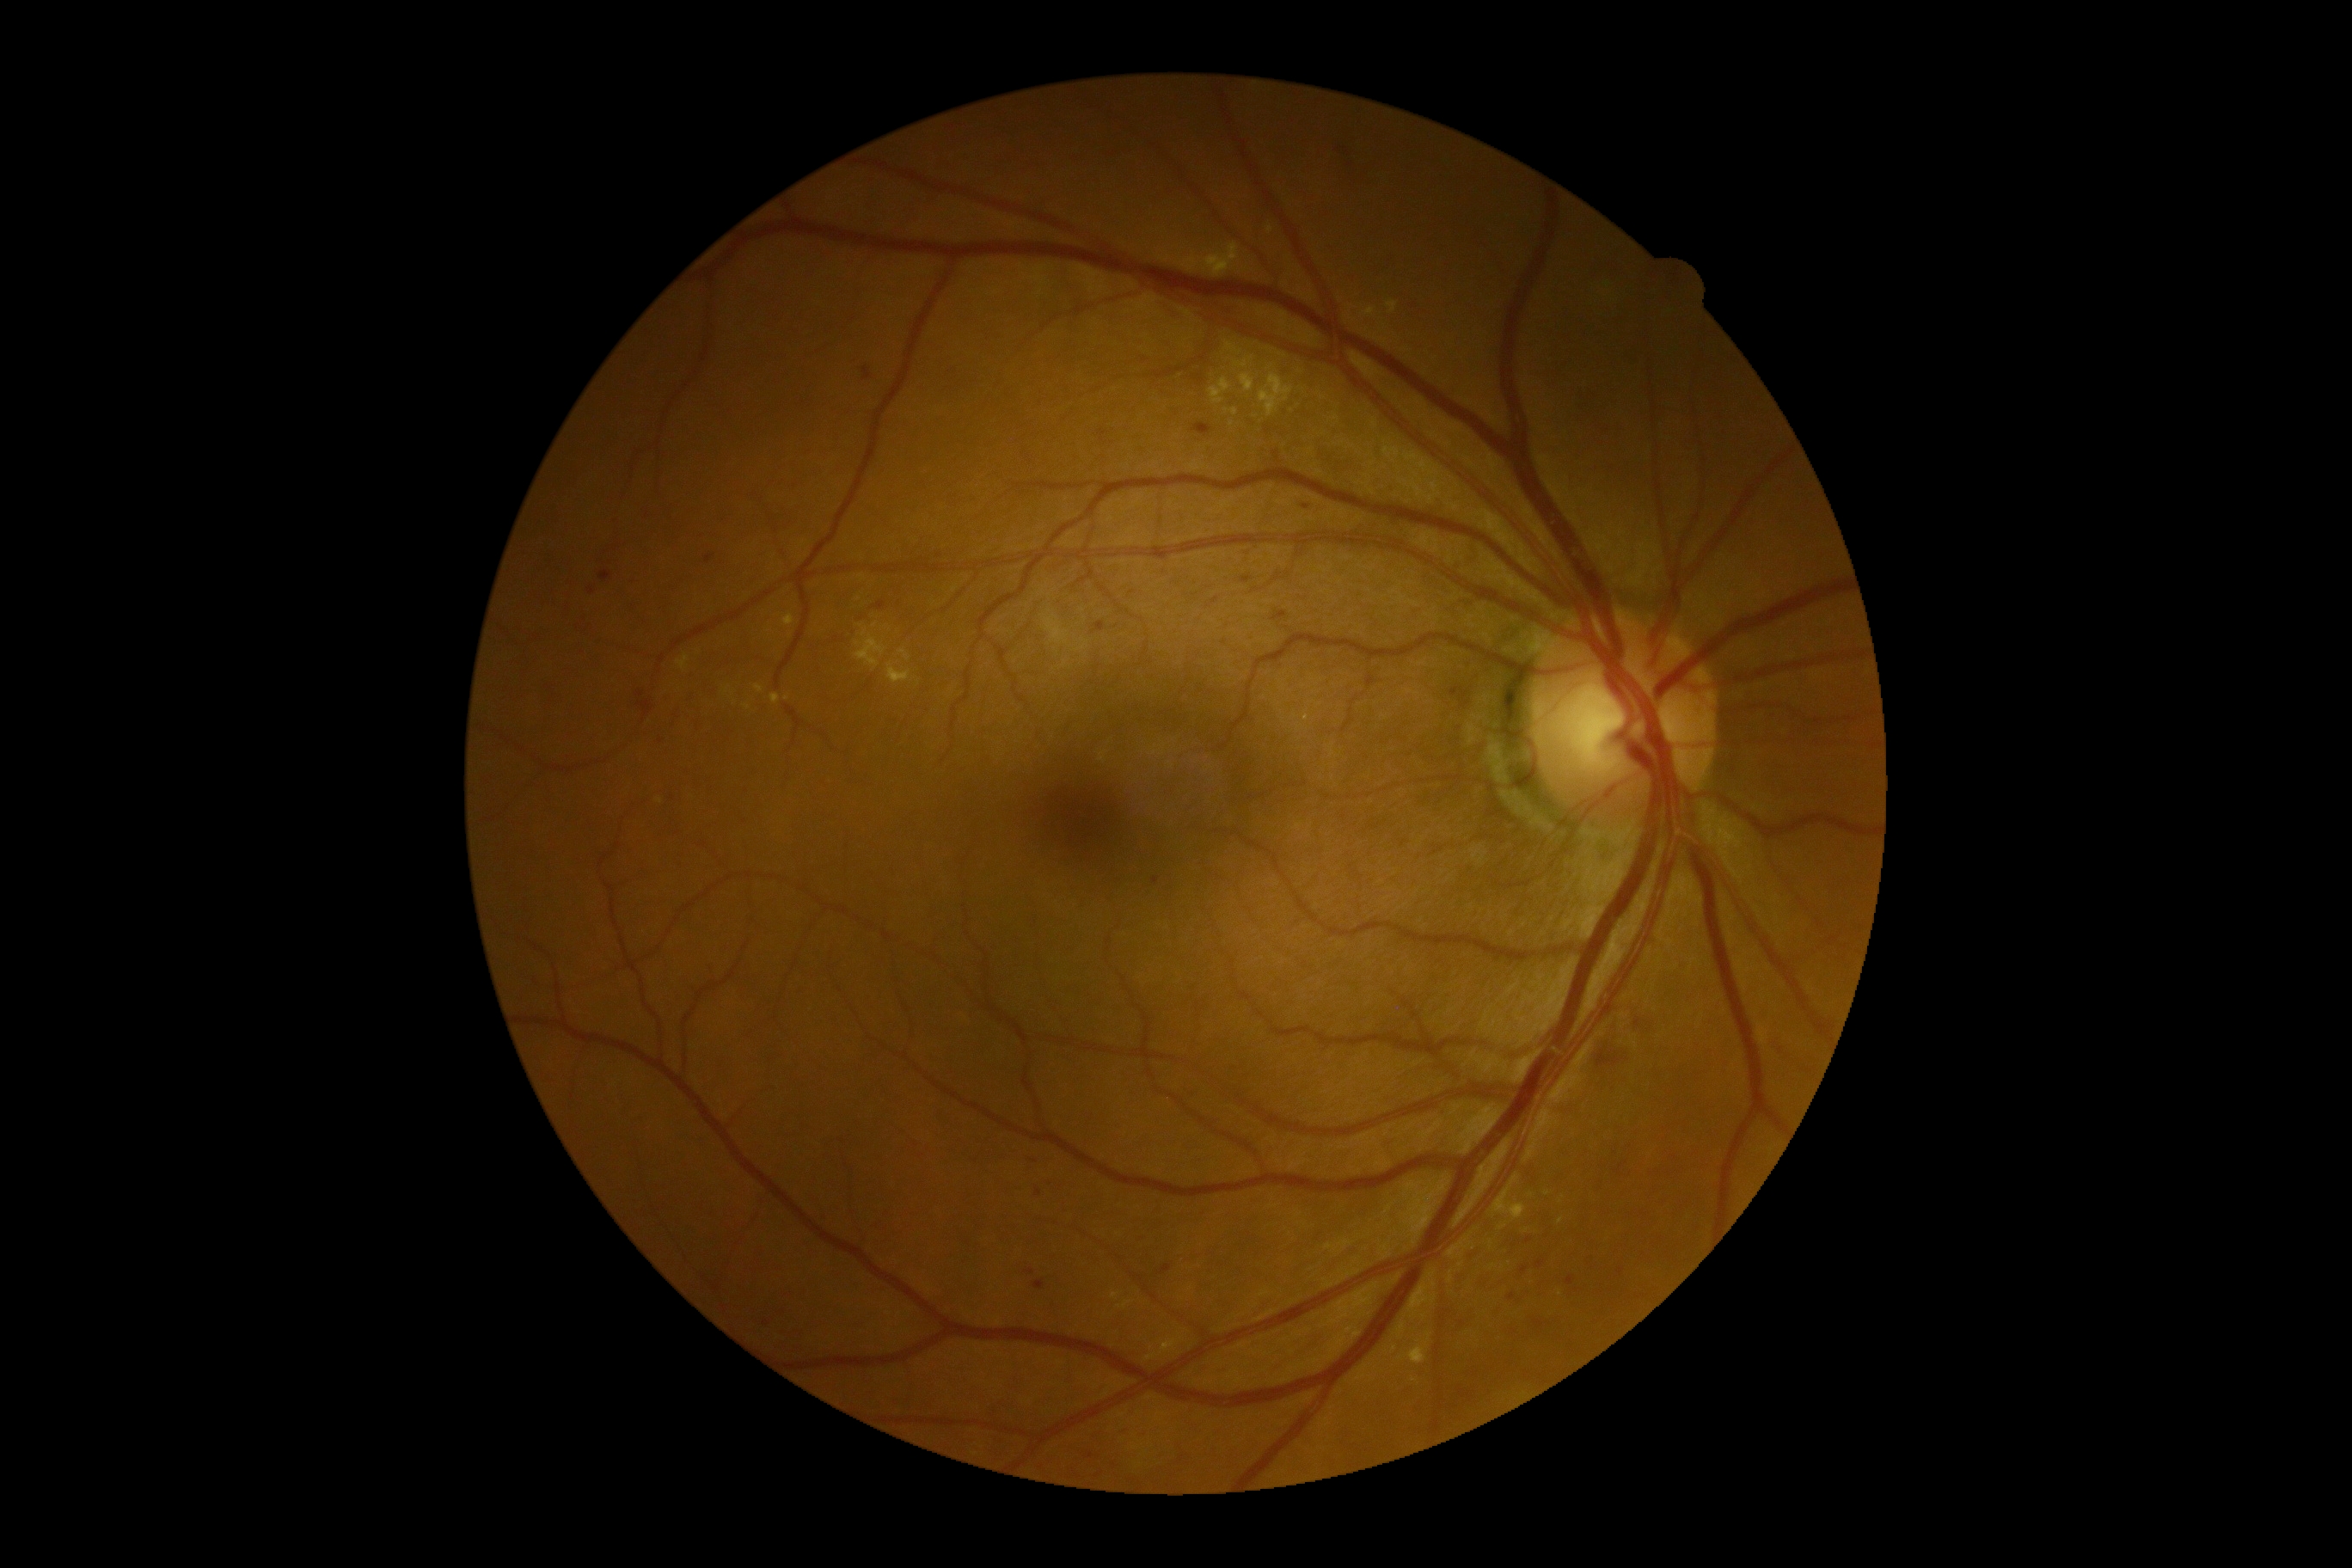

Disease class: non-proliferative diabetic retinopathy.
Diabetic retinopathy grade: 2 — more than just microaneurysms but less than severe NPDR.